Camera: Clarity RetCam 3 (130° FOV) · pediatric wide-field fundus photograph · 640x480
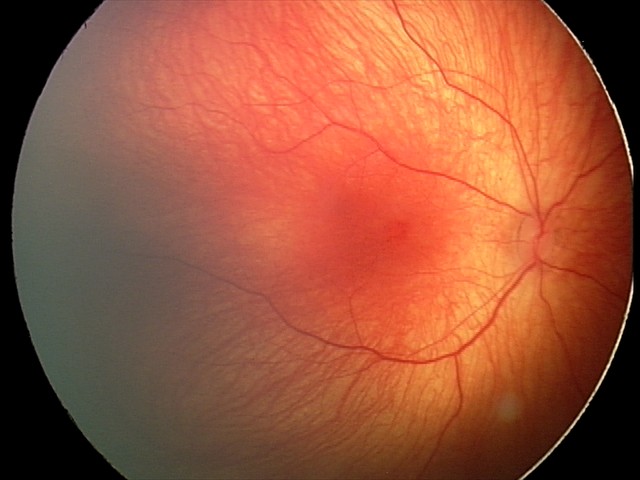
Impression: retinal hemorrhages.